Camera: Phoenix ICON (100° FOV); 1240 by 1240 pixels; infant wide-field fundus photograph
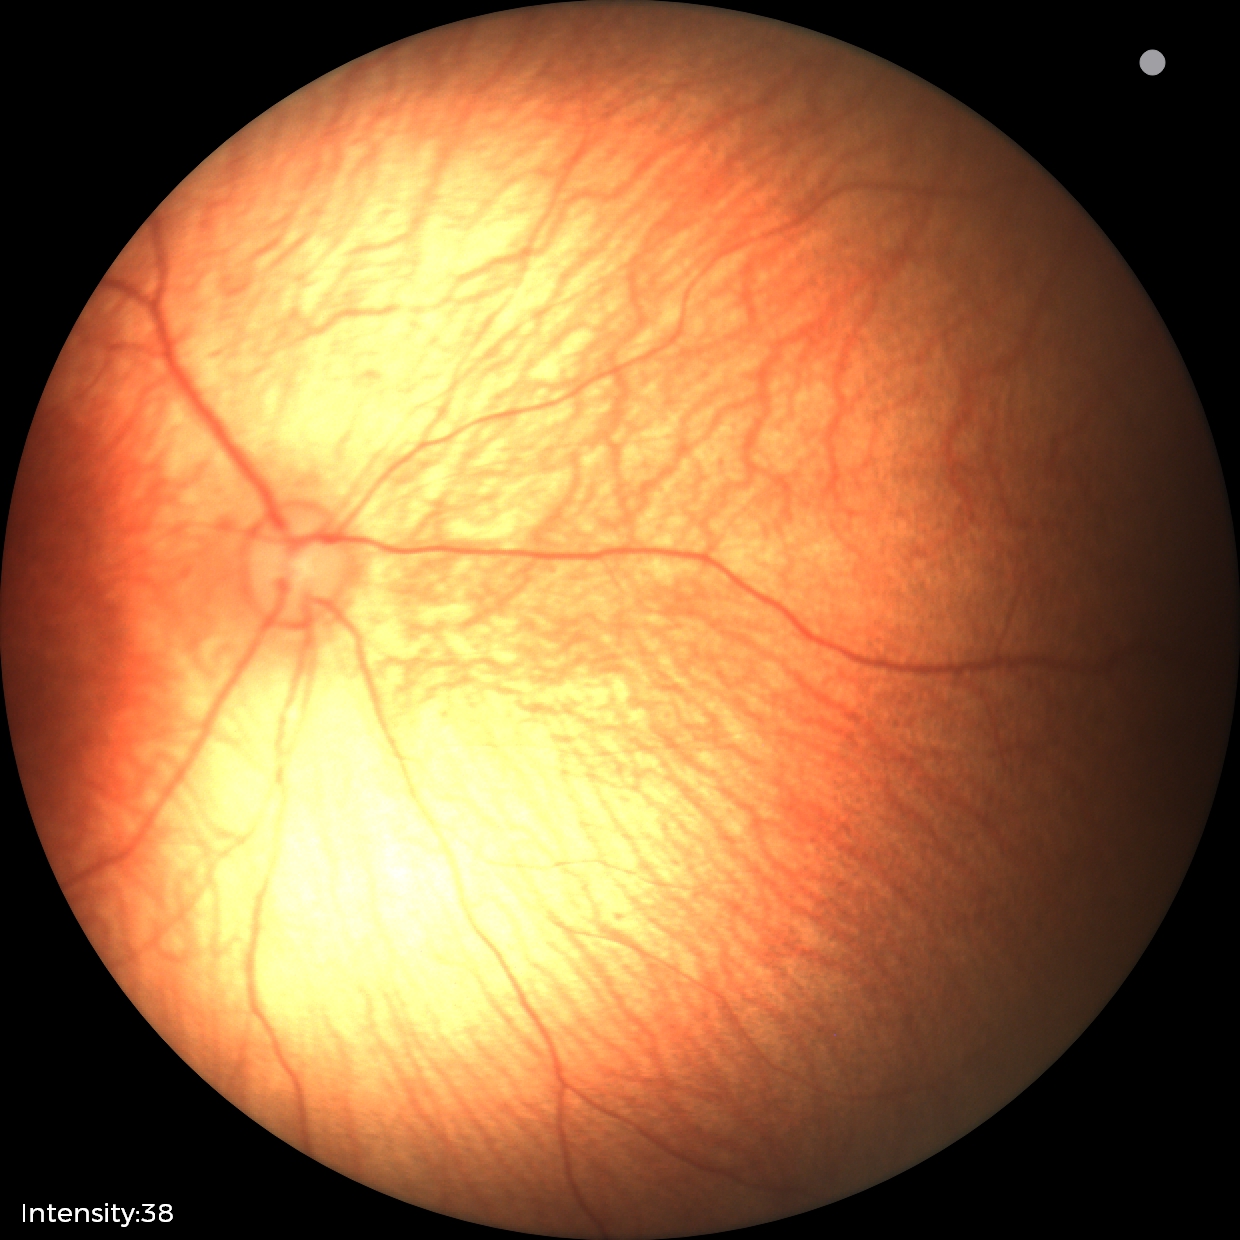 Normal screening examination.